Modified Davis grading: 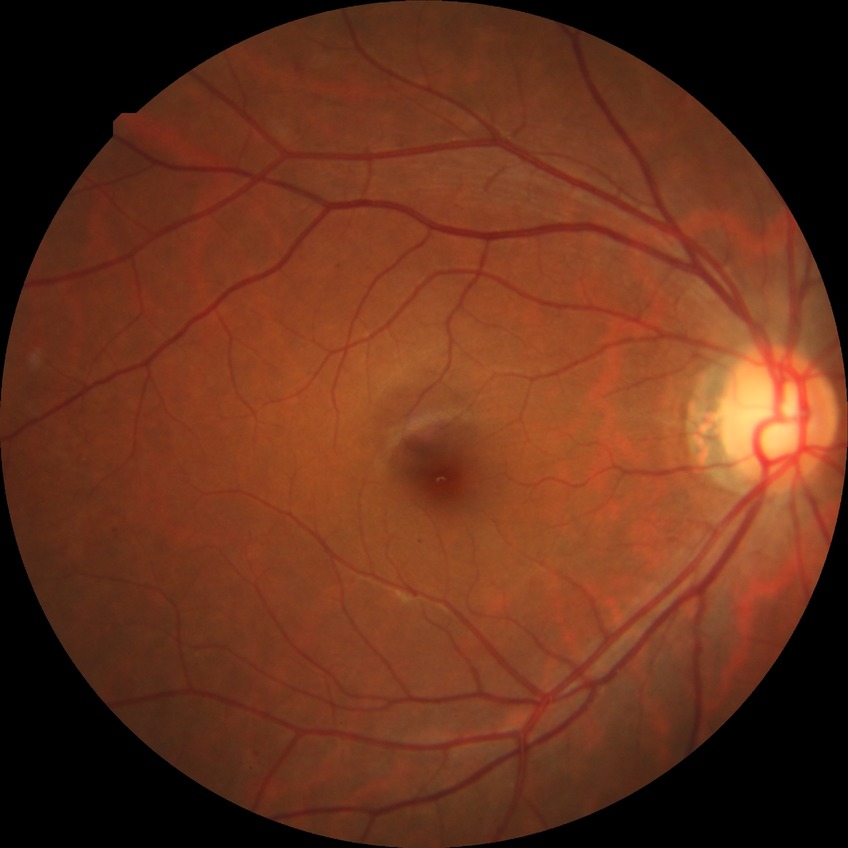

diabetic retinopathy (DR): simple diabetic retinopathy (SDR).